Pediatric retinal photograph (wide-field): 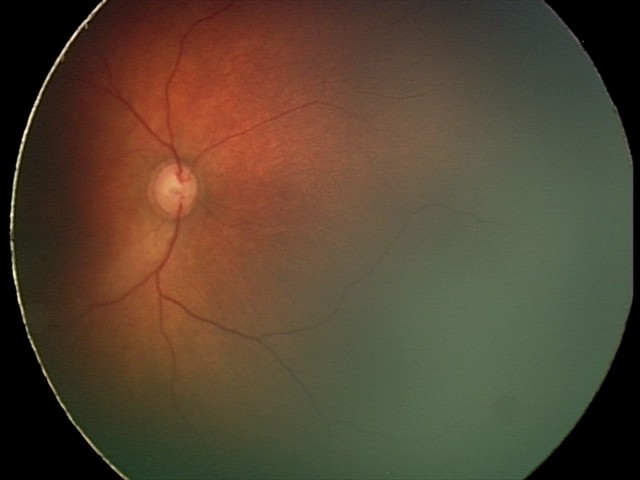

Screening diagnosis: physiological retinal finding.